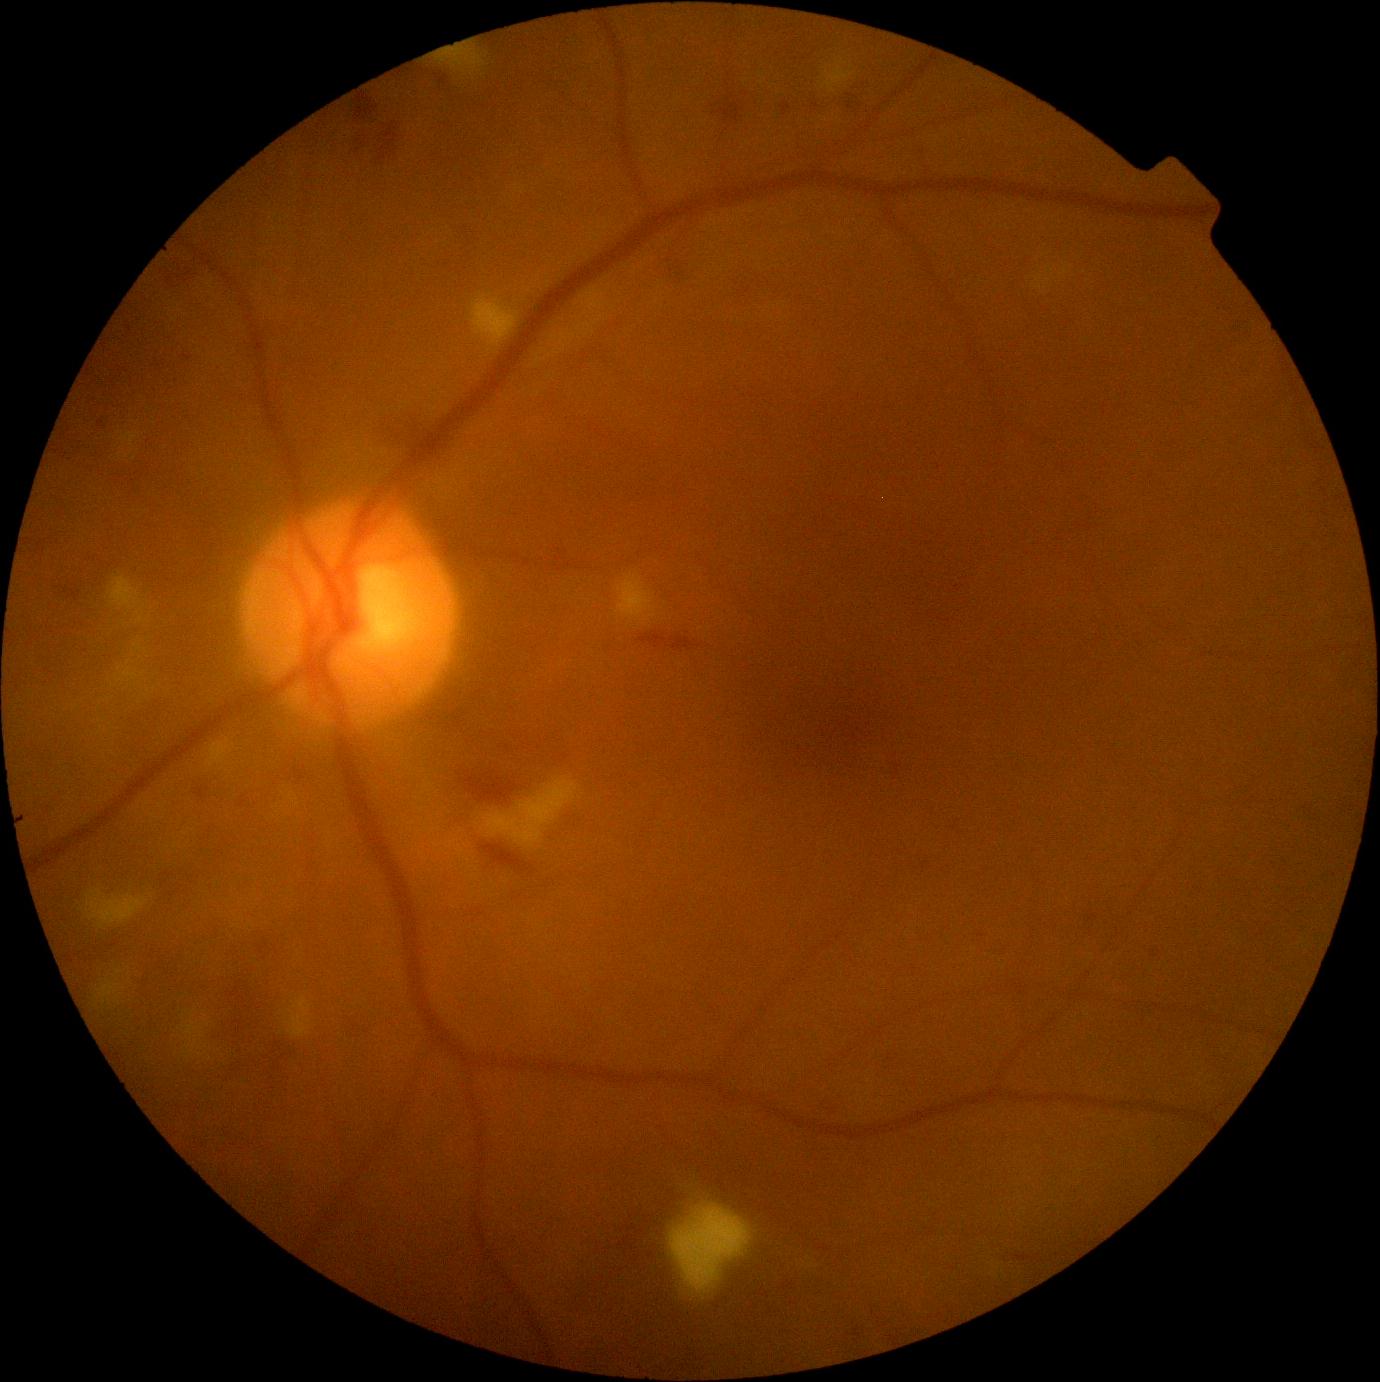
DR stage is grade 2 — more than just microaneurysms but less than severe NPDR.